45° field of view · 2352 x 1568 pixels · CFP — 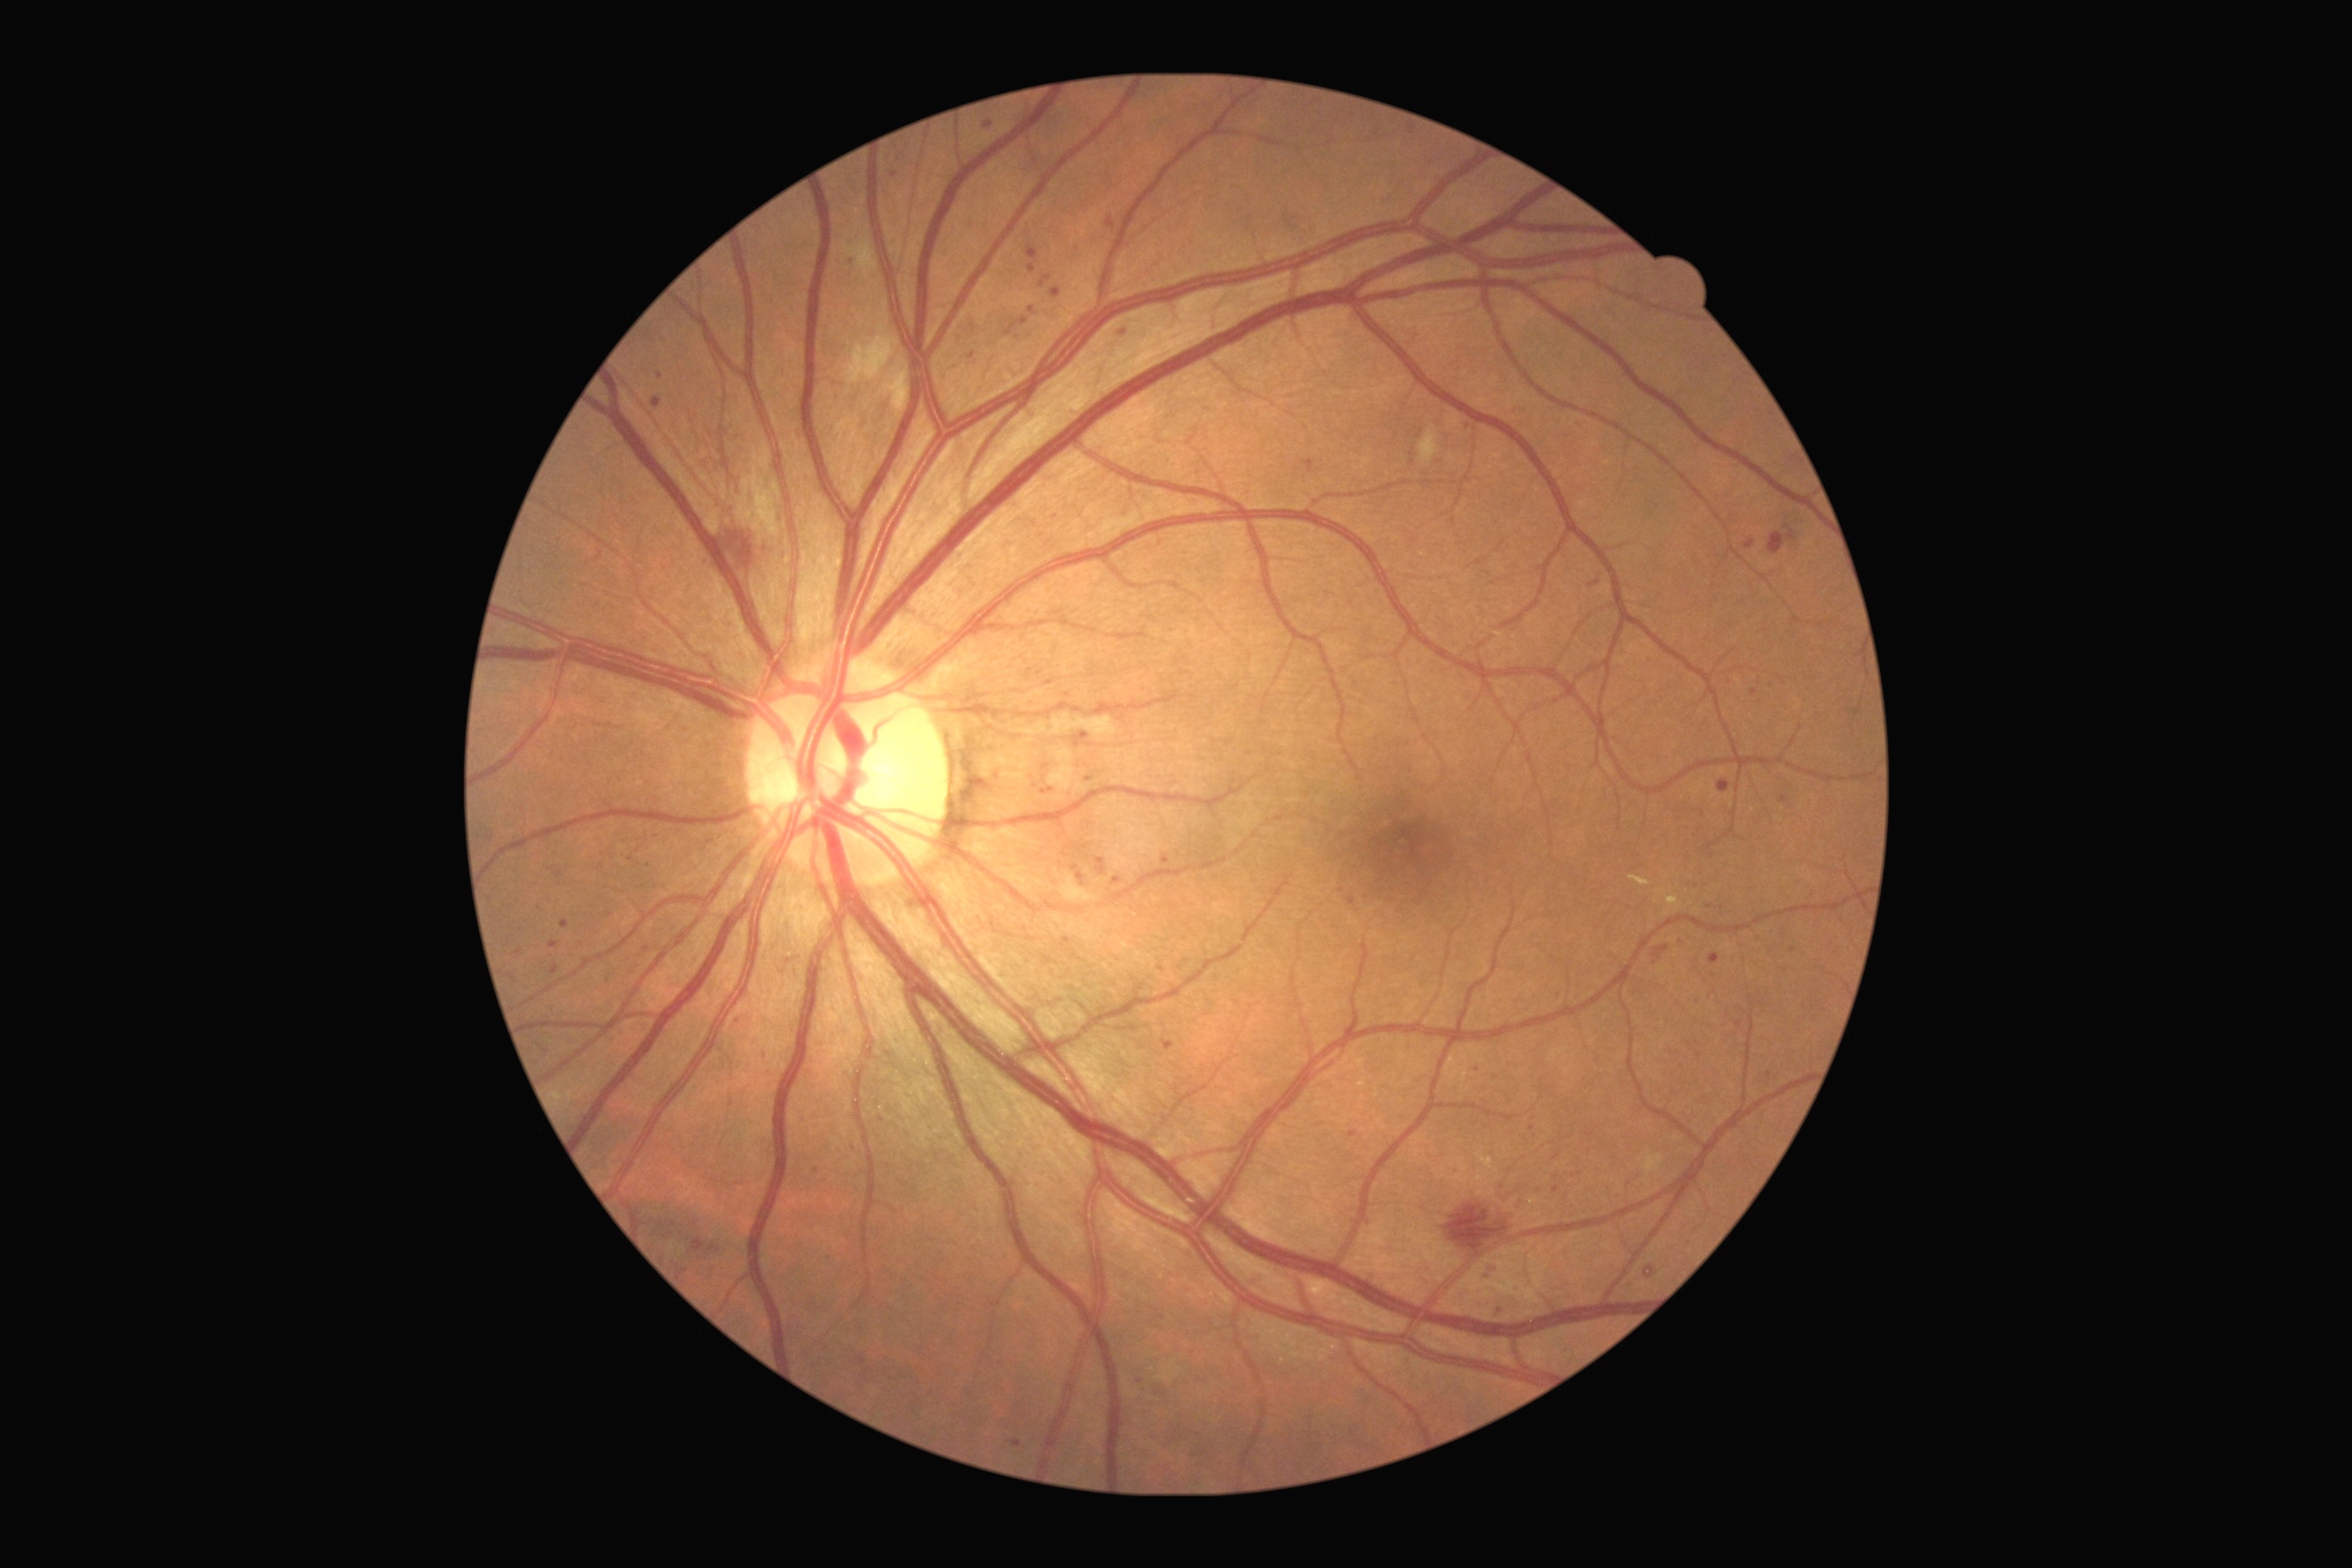
DR stage is severe NPDR (grade 3).